45° field of view · 2368 by 1568 pixels
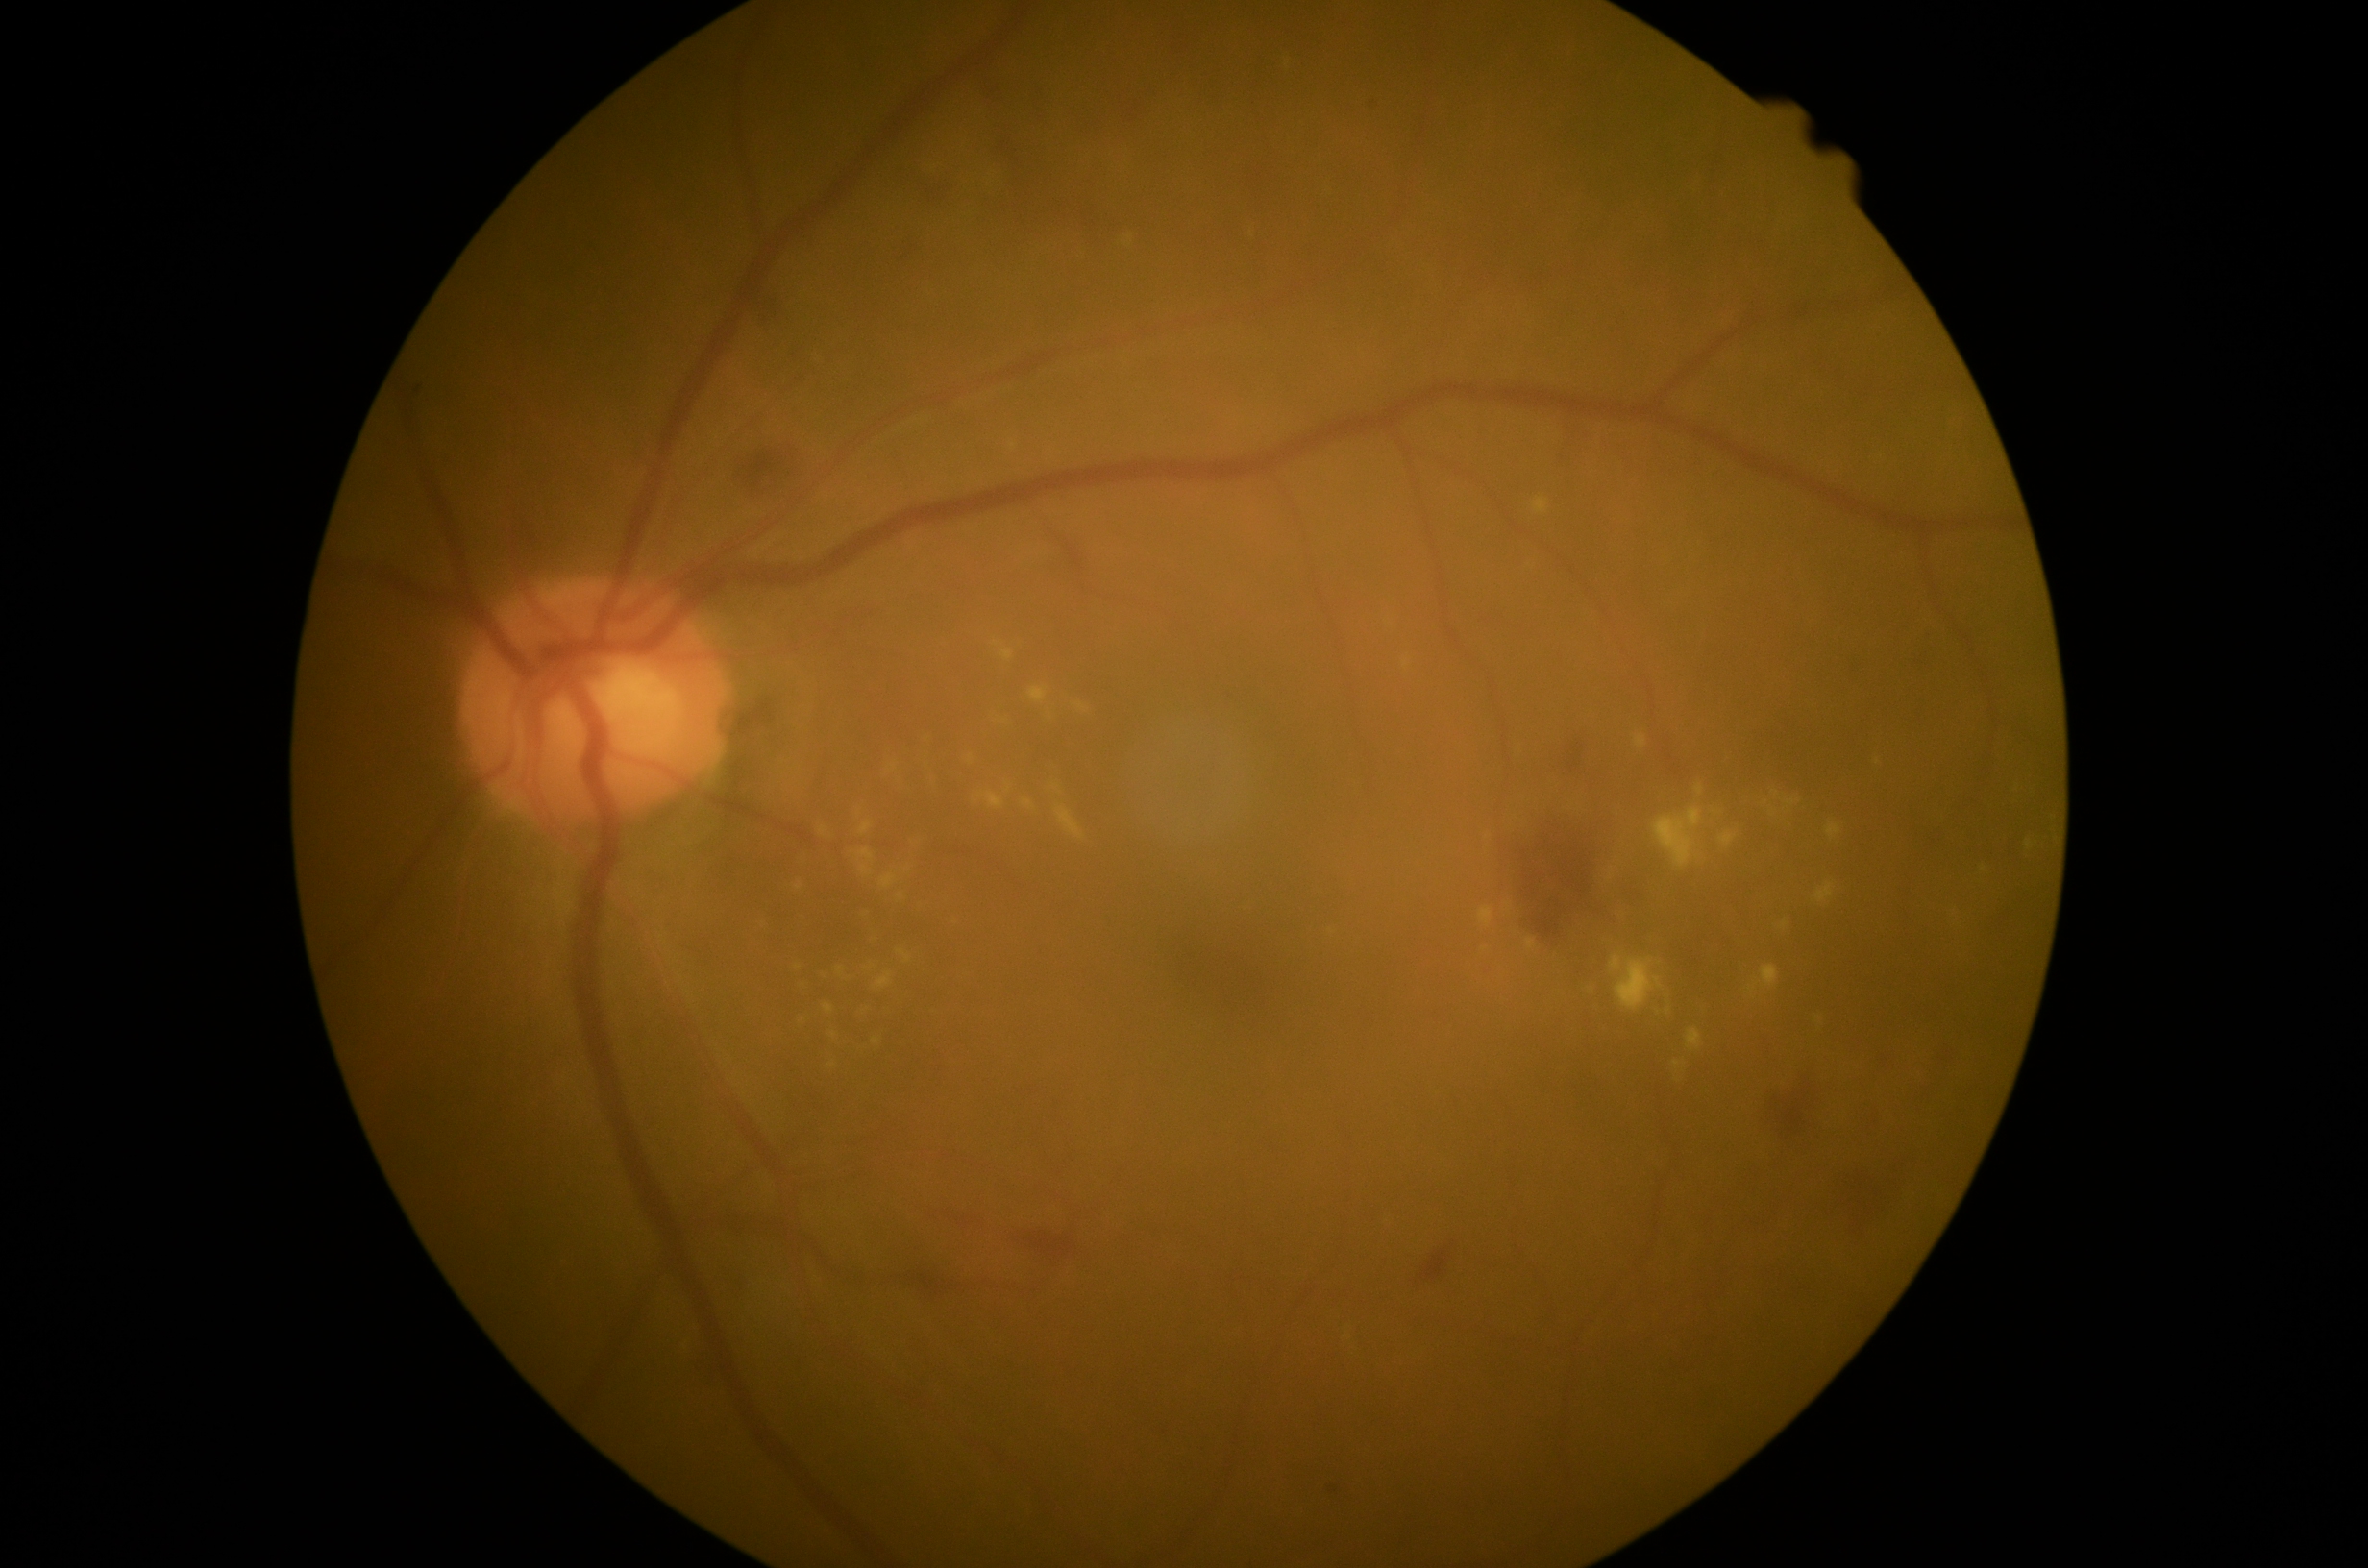 DR grade: 2. EXs include lesions at 825/1005/835/1016; 821/828/828/838; 1055/807/1085/840; 1076/704/1089/712; 859/821/874/837; 1674/1063/1683/1069; 857/848/875/876; 1479/908/1495/929; 900/951/911/965; 1688/1029/1702/1050. Small EXs approximately at pt(908, 871); pt(998, 645); pt(799, 967); pt(800, 887); pt(1611, 880); pt(1489, 837).